Color fundus image.
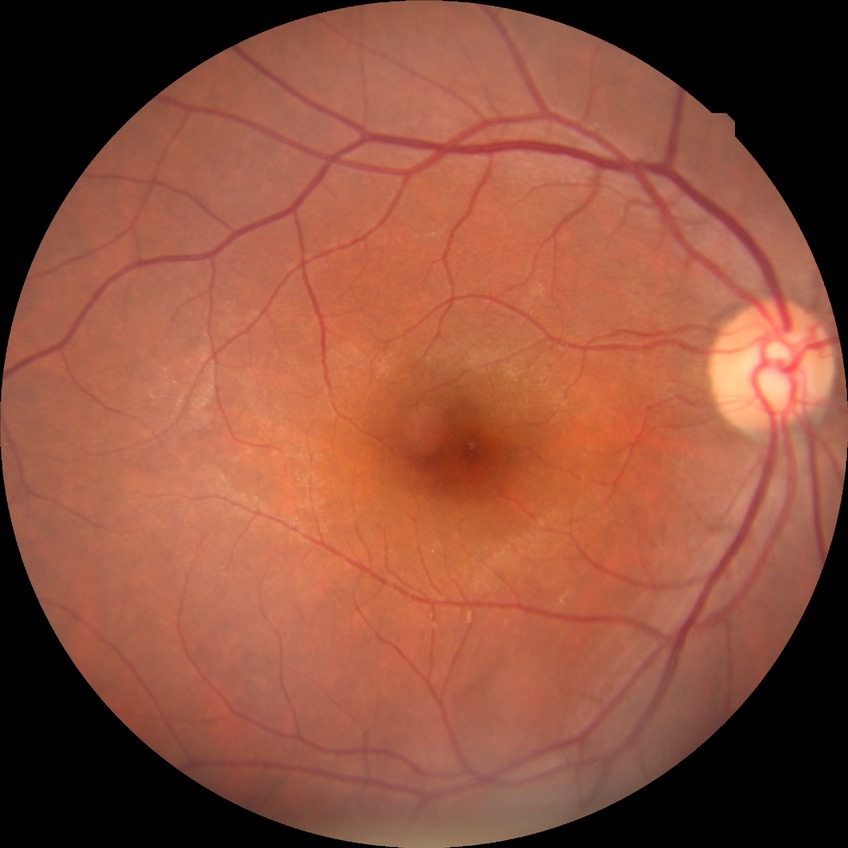   davis_grade: NDR (no diabetic retinopathy)